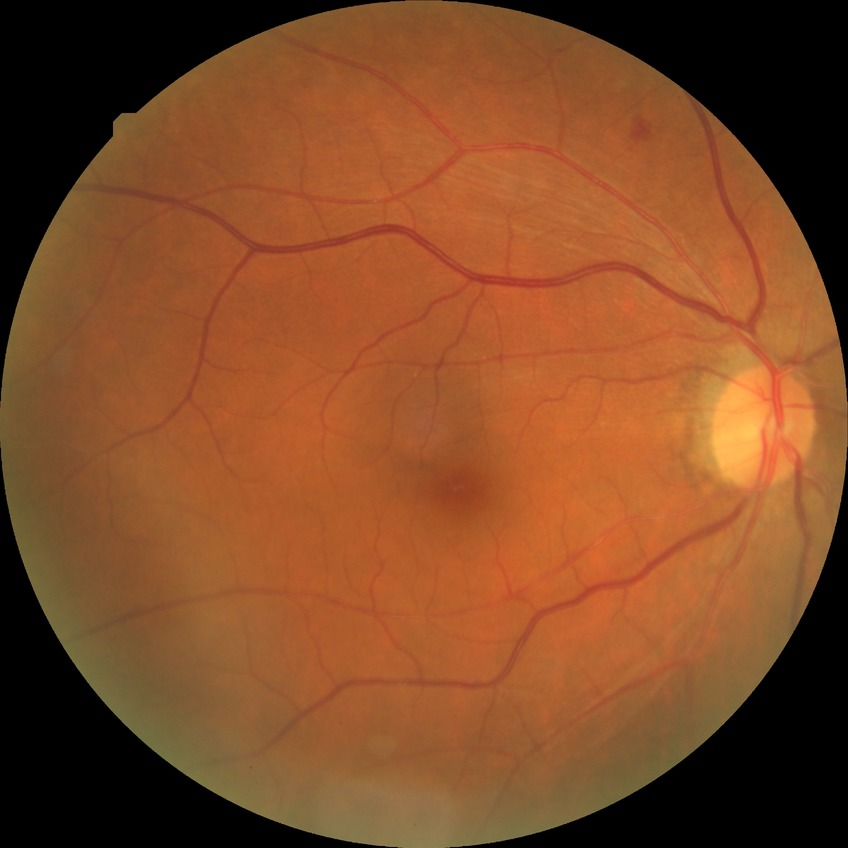
Diabetic retinopathy (DR): SDR (simple diabetic retinopathy).
Disease class: non-proliferative diabetic retinopathy.